Posterior pole color fundus photograph · 45 degree fundus photograph · graded on the modified Davis scale · 848x848px:
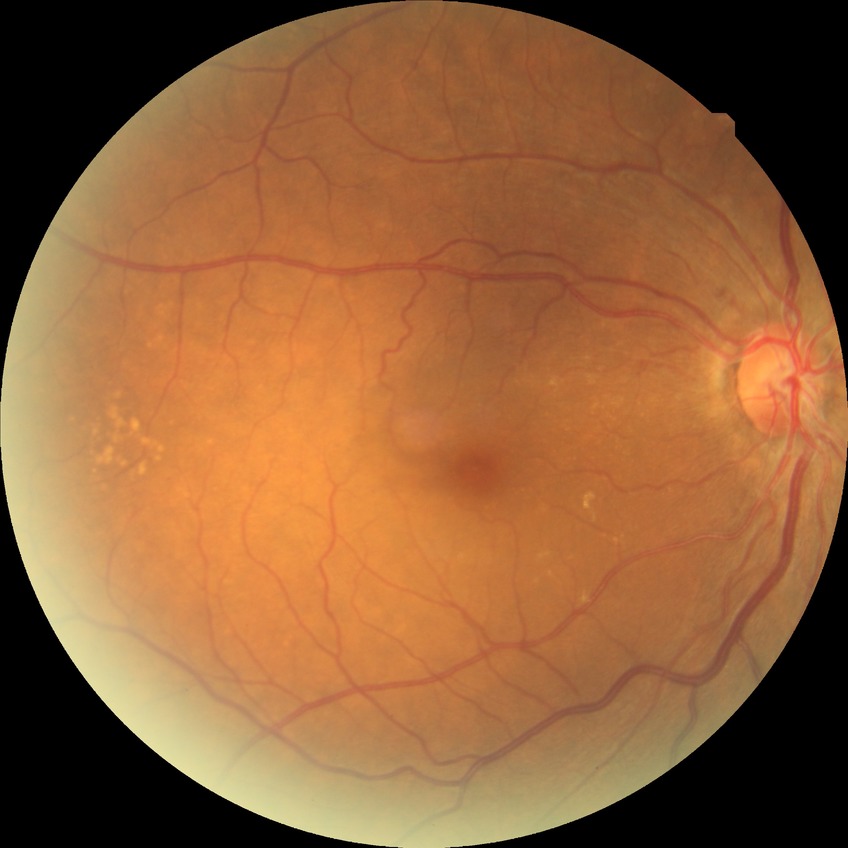

Findings:
– Davis grade — NDR